1240x1240; wide-field fundus photograph from neonatal ROP screening — 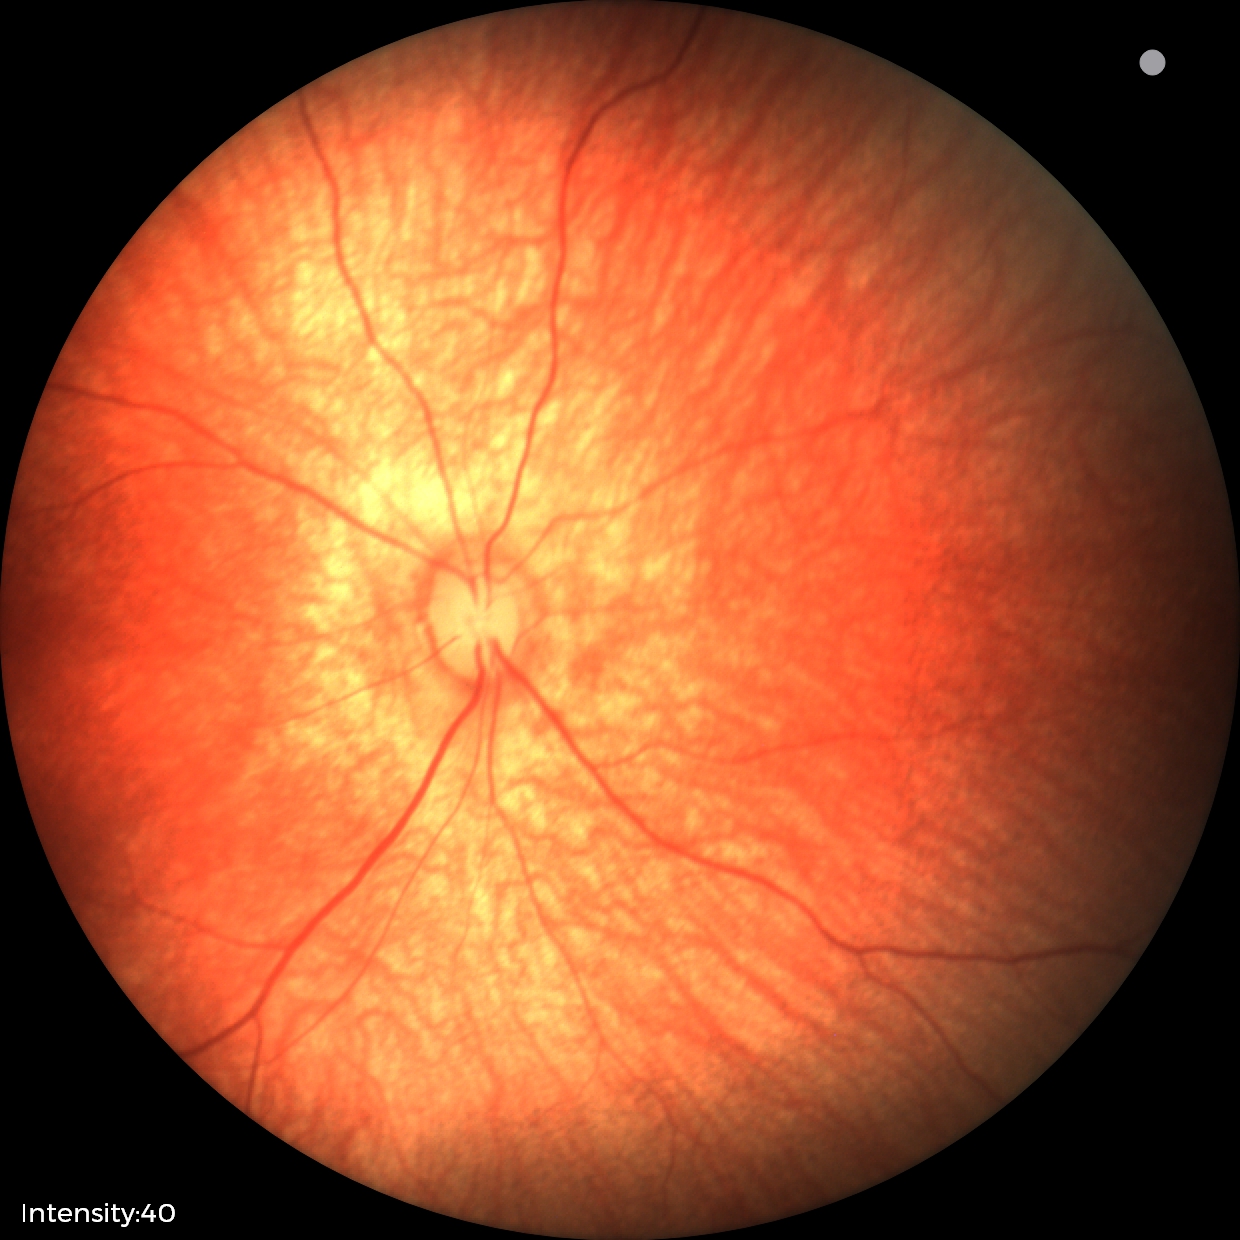

Normal screening examination.